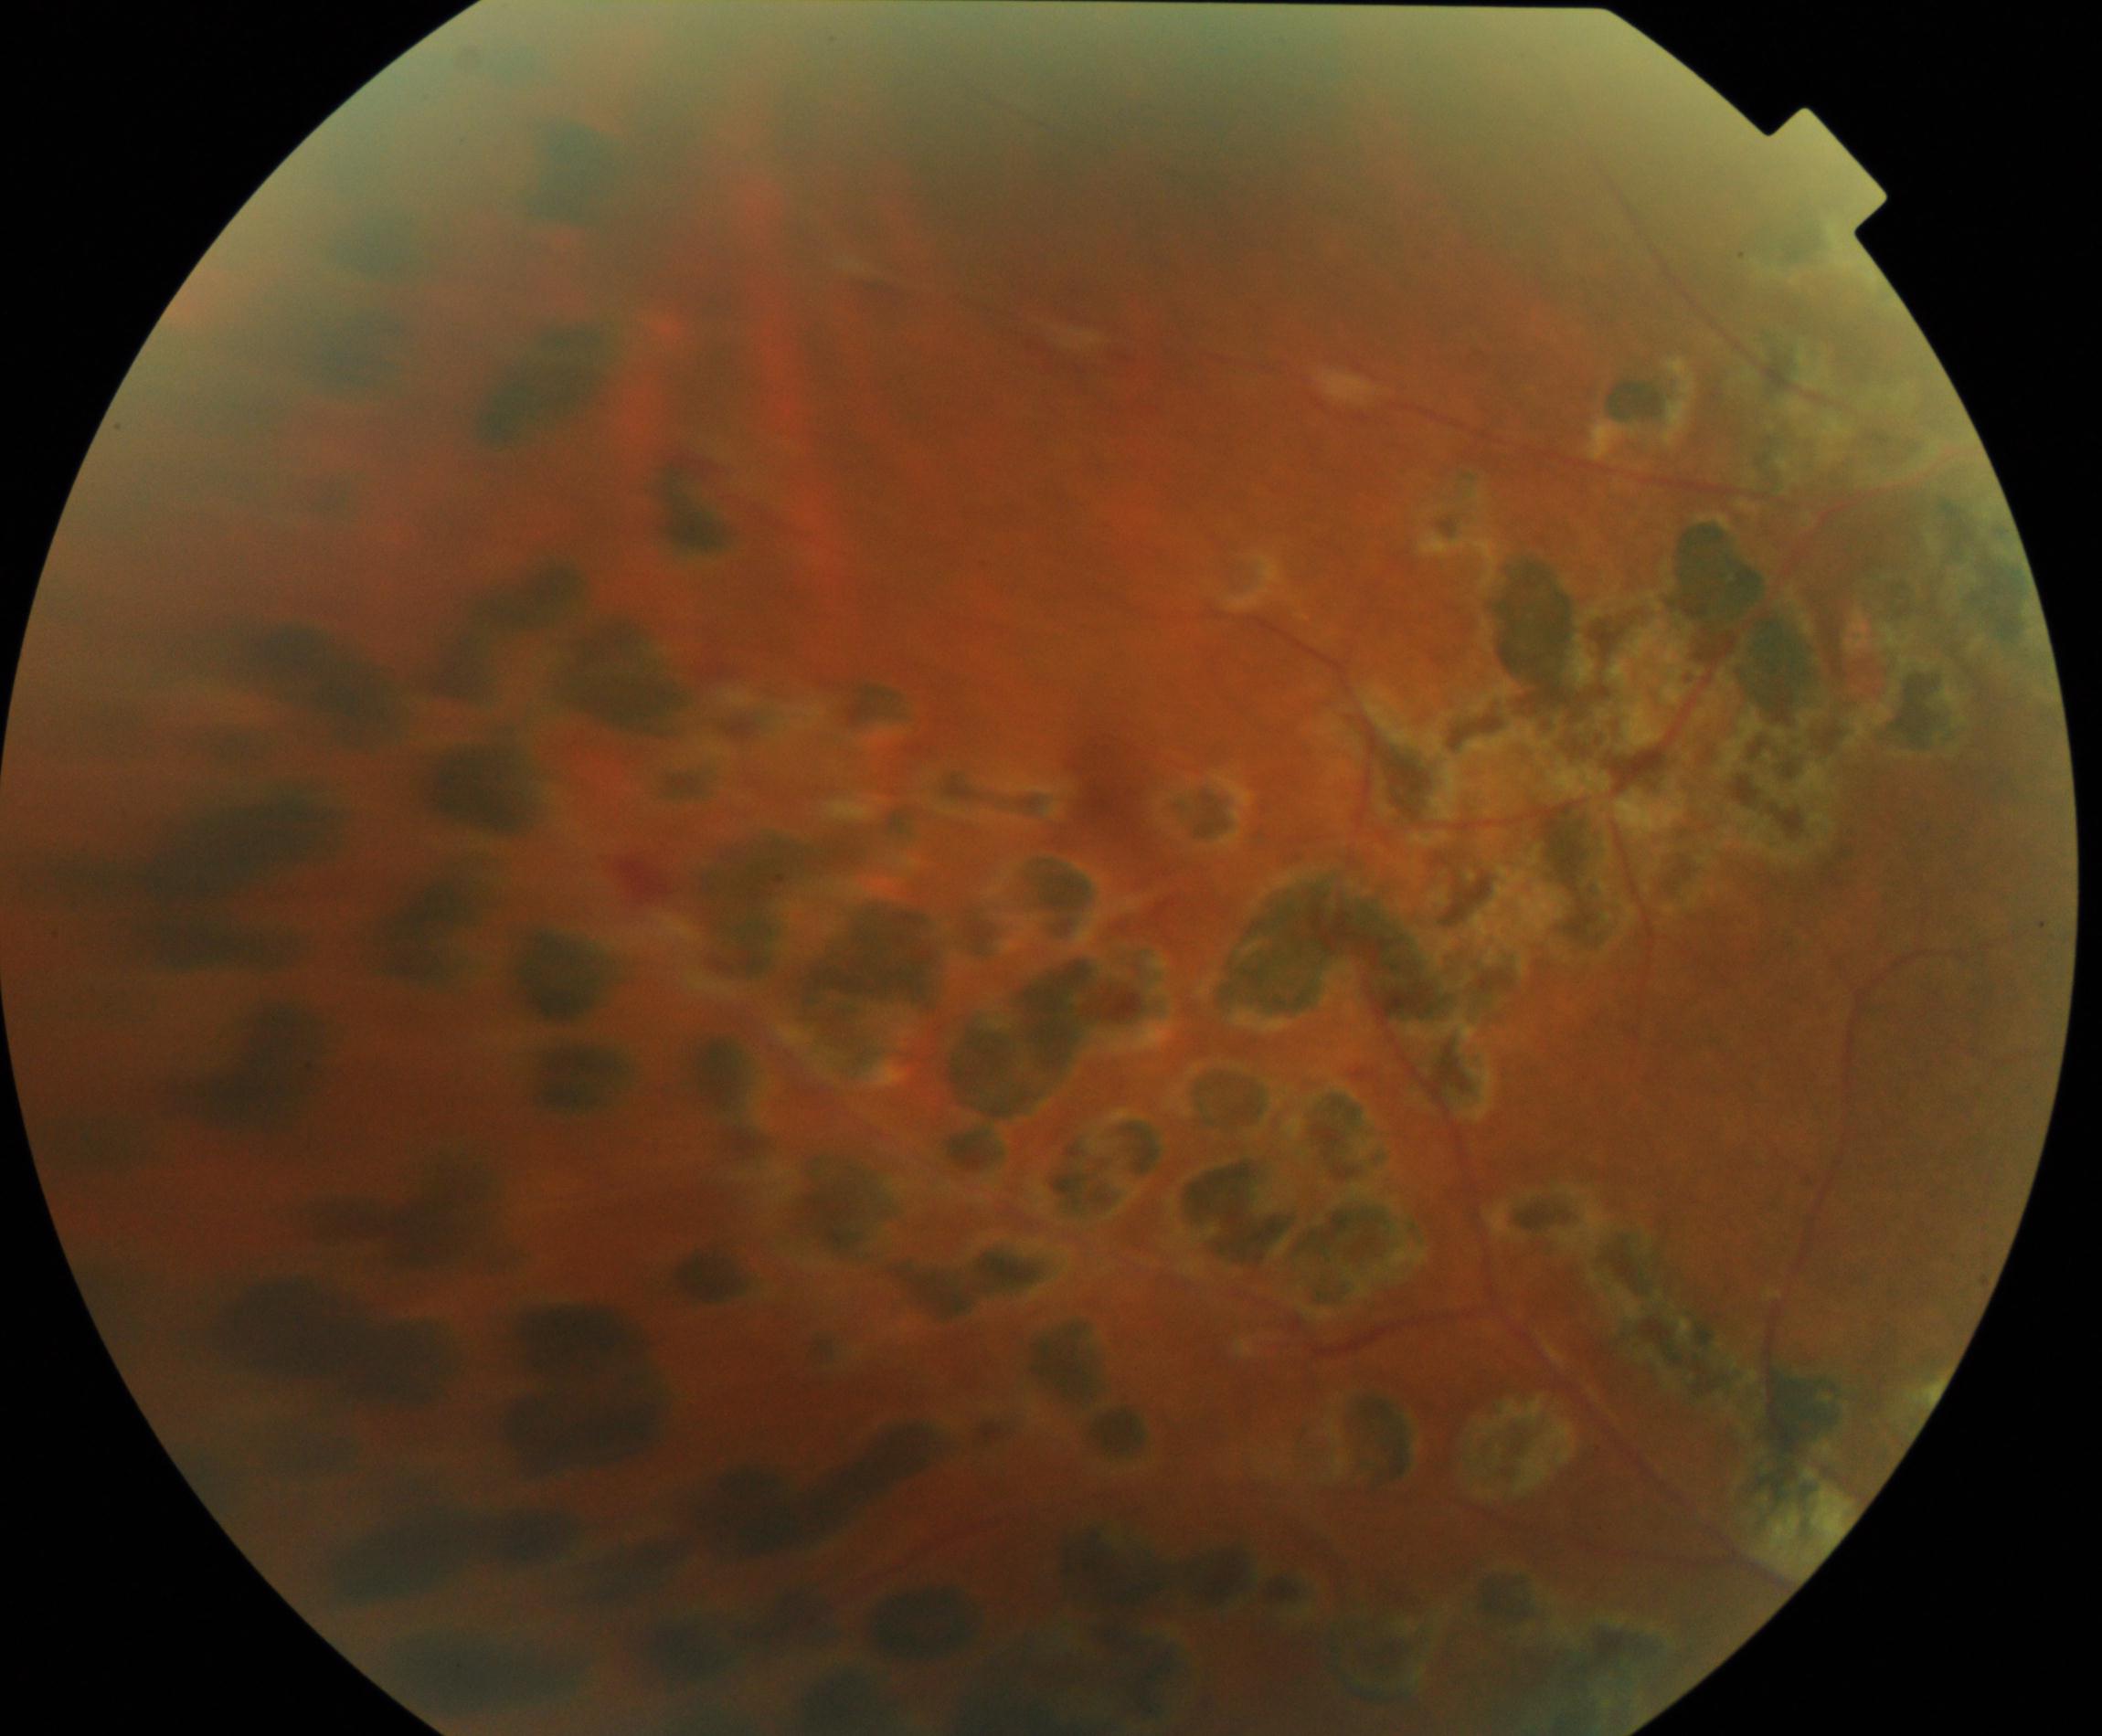

This fundus photograph shows laser spots.